45-degree field of view.
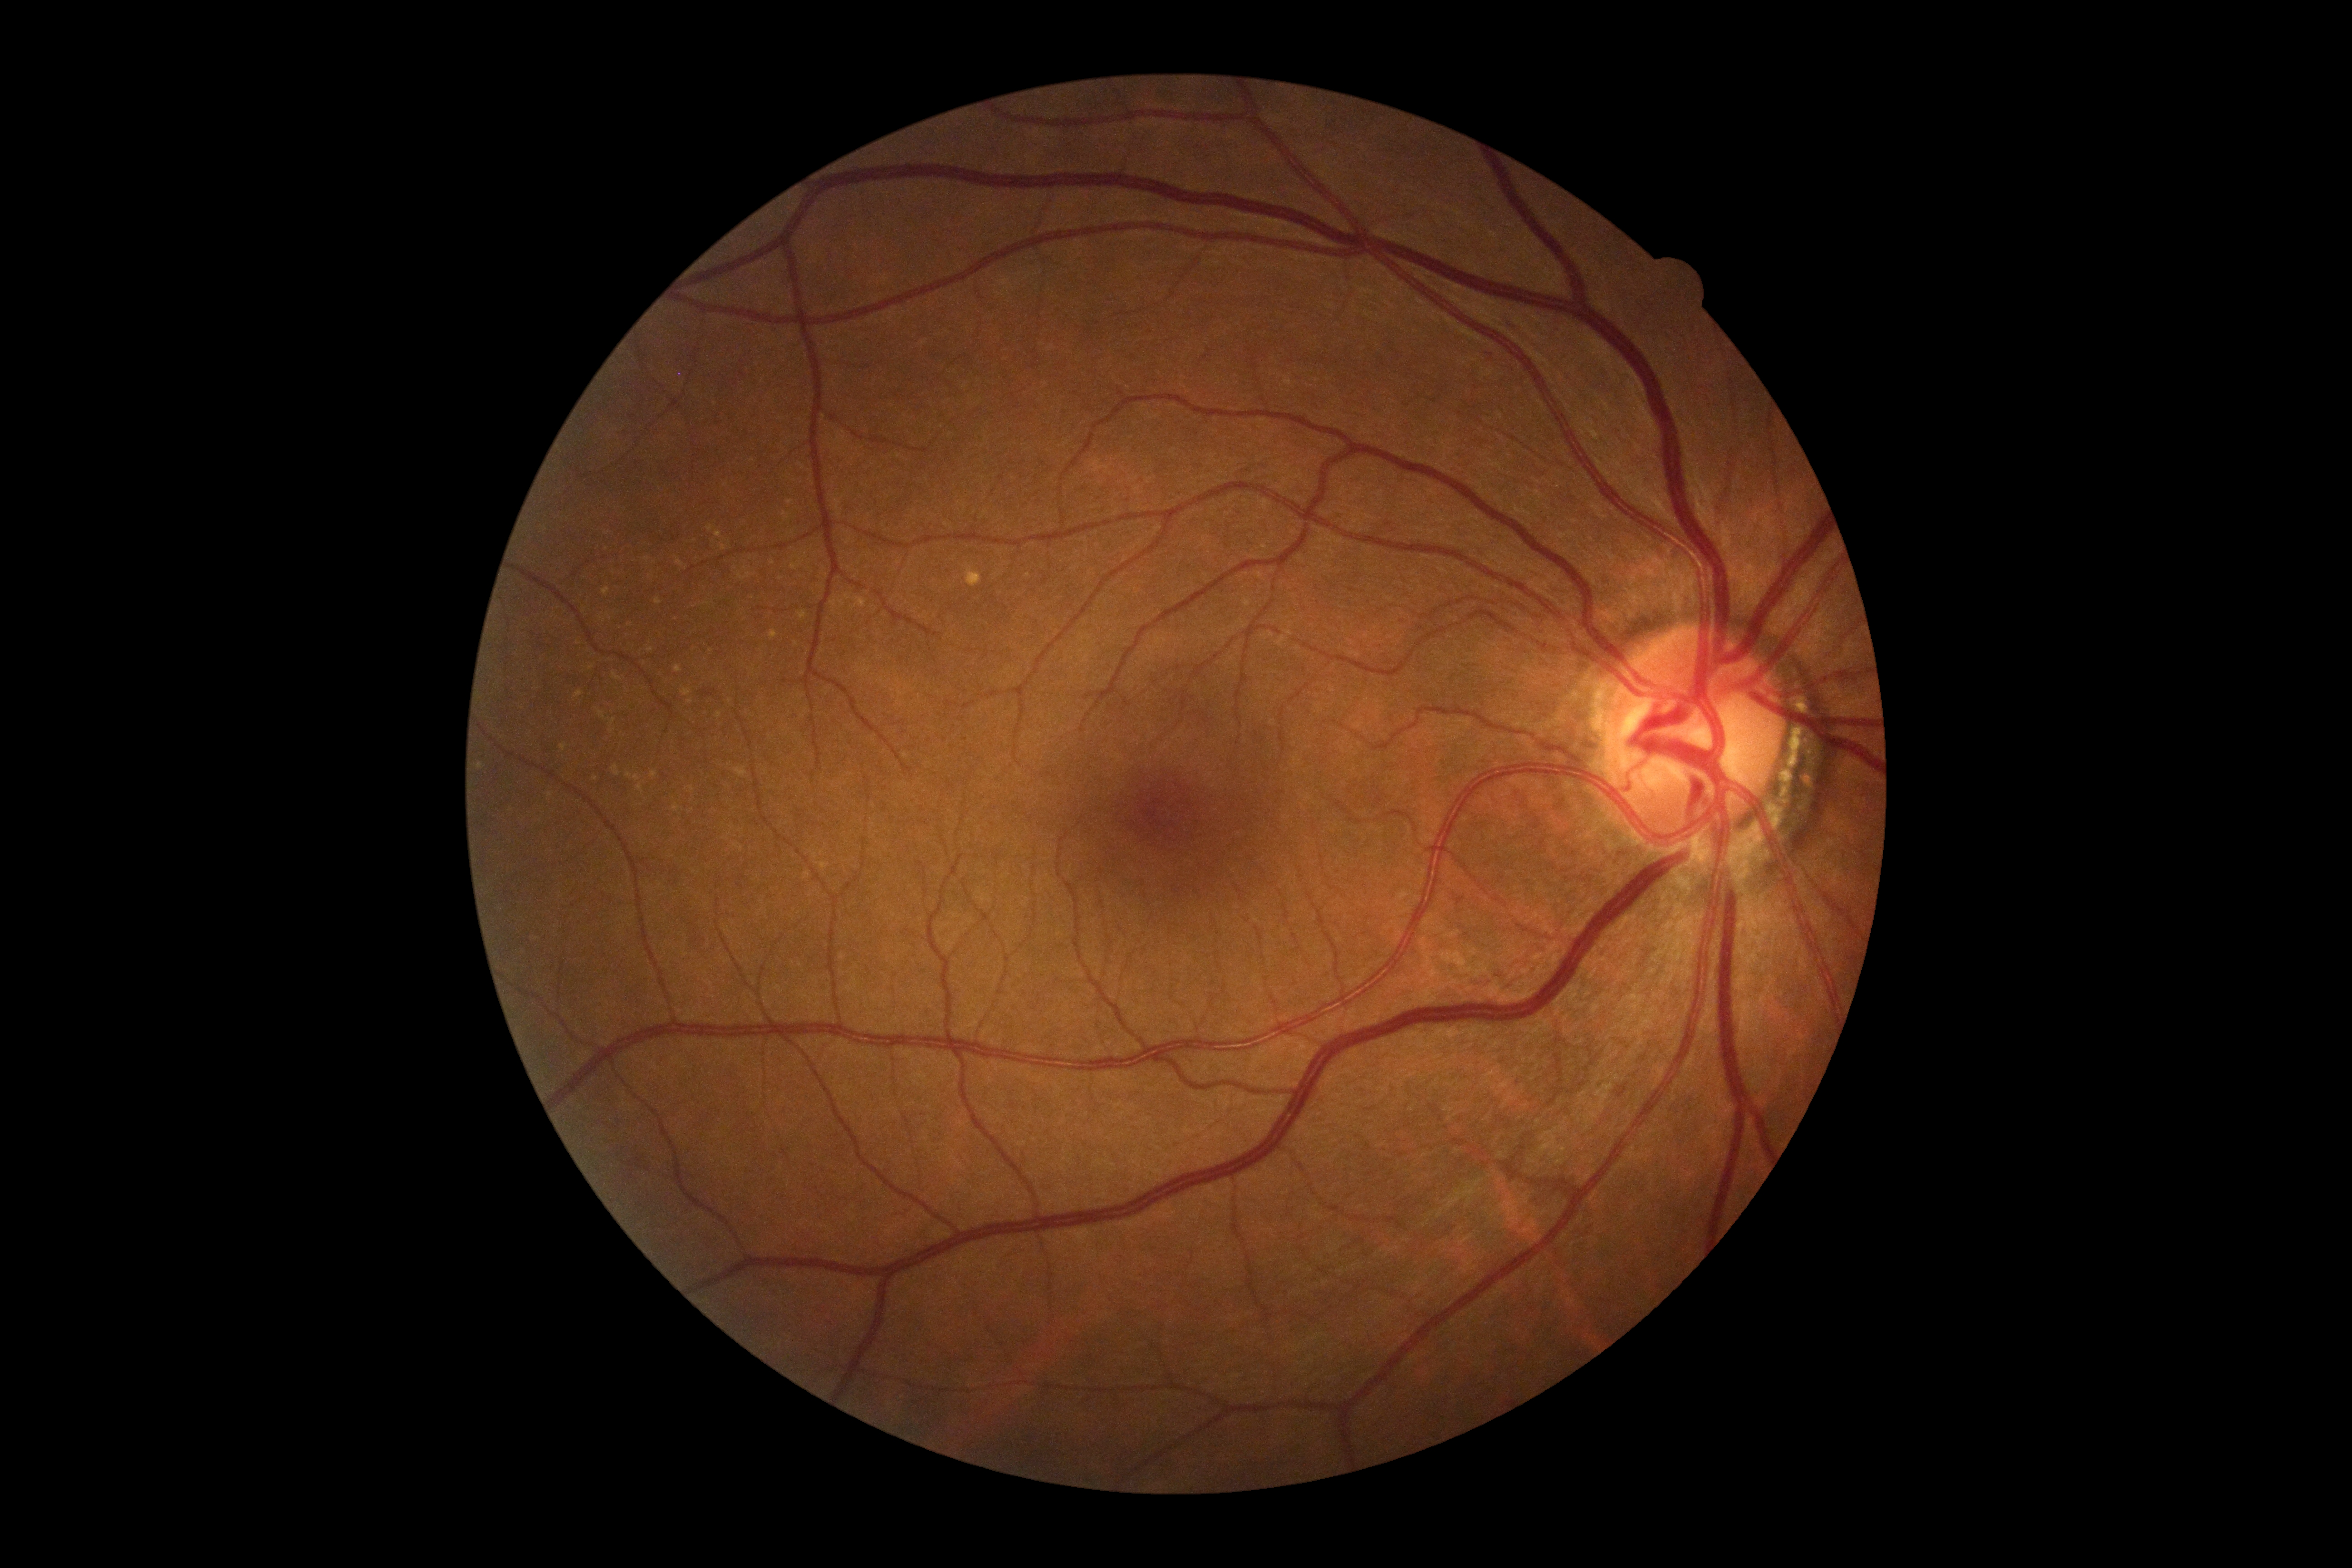

retinopathy: no apparent diabetic retinopathy (grade 0)